1932x1932 · fundus photo · FOV: 45 degrees
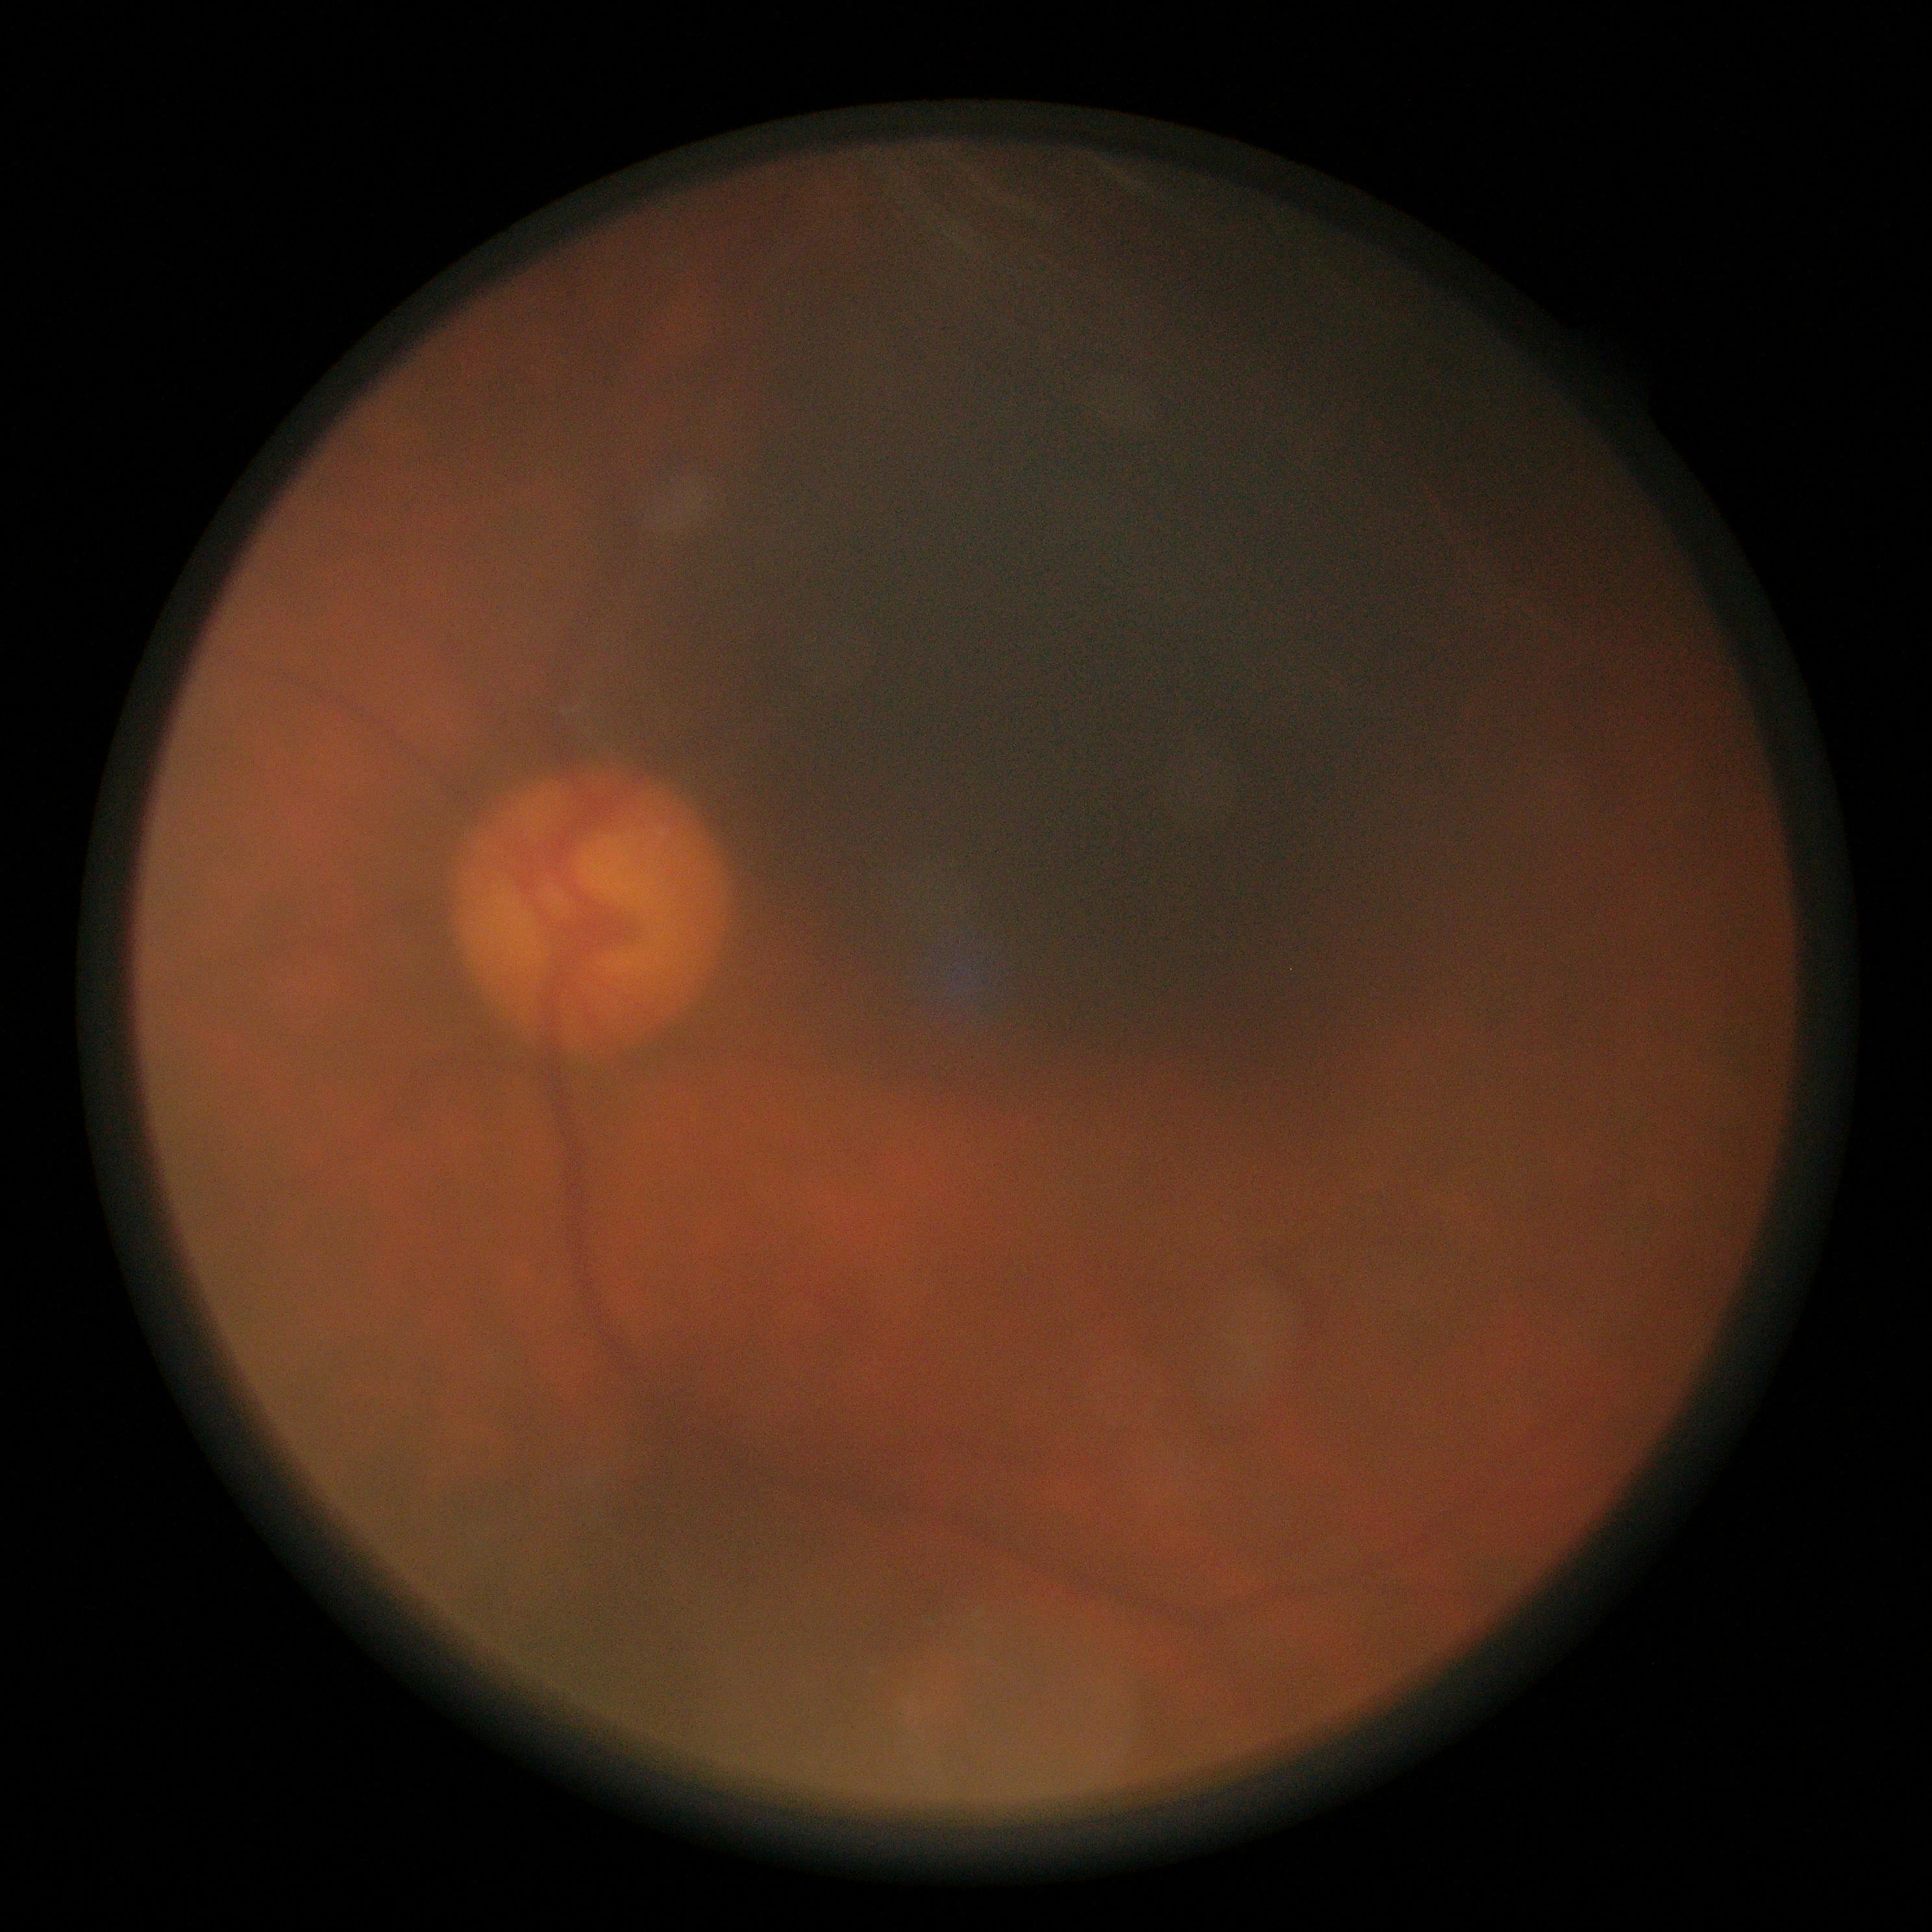
  dr_grade: ungradable